Modified Davis classification. NIDEK AFC-230 fundus camera — 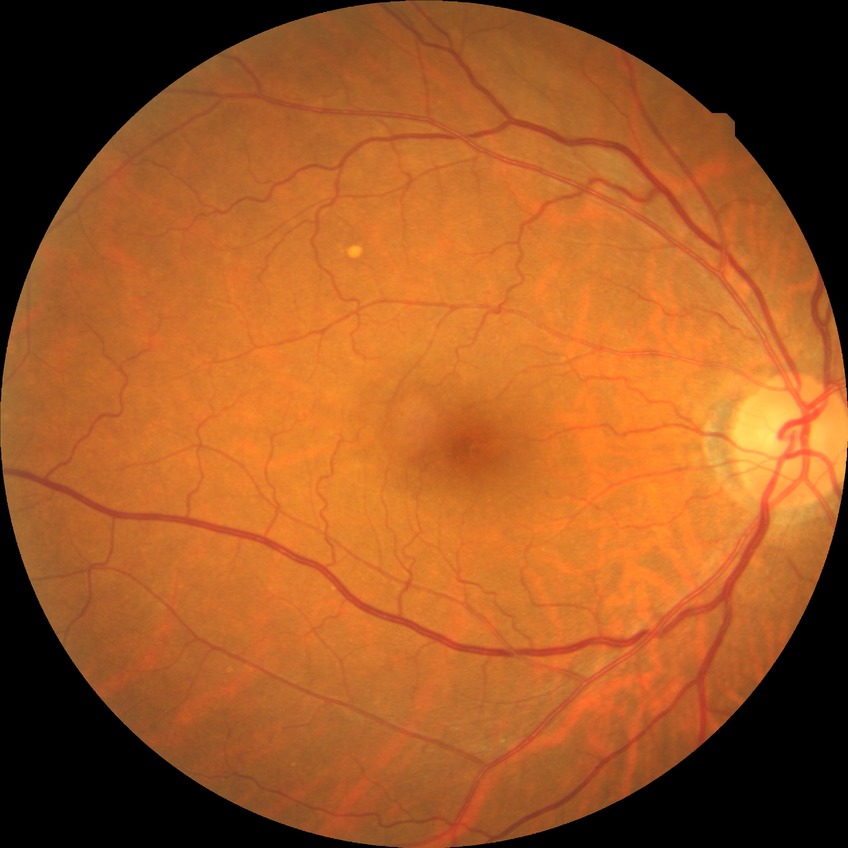 Retinopathy grade is no diabetic retinopathy.